Image size 1924x1556, FOV: 200 degrees, ultra-widefield fundus photograph: 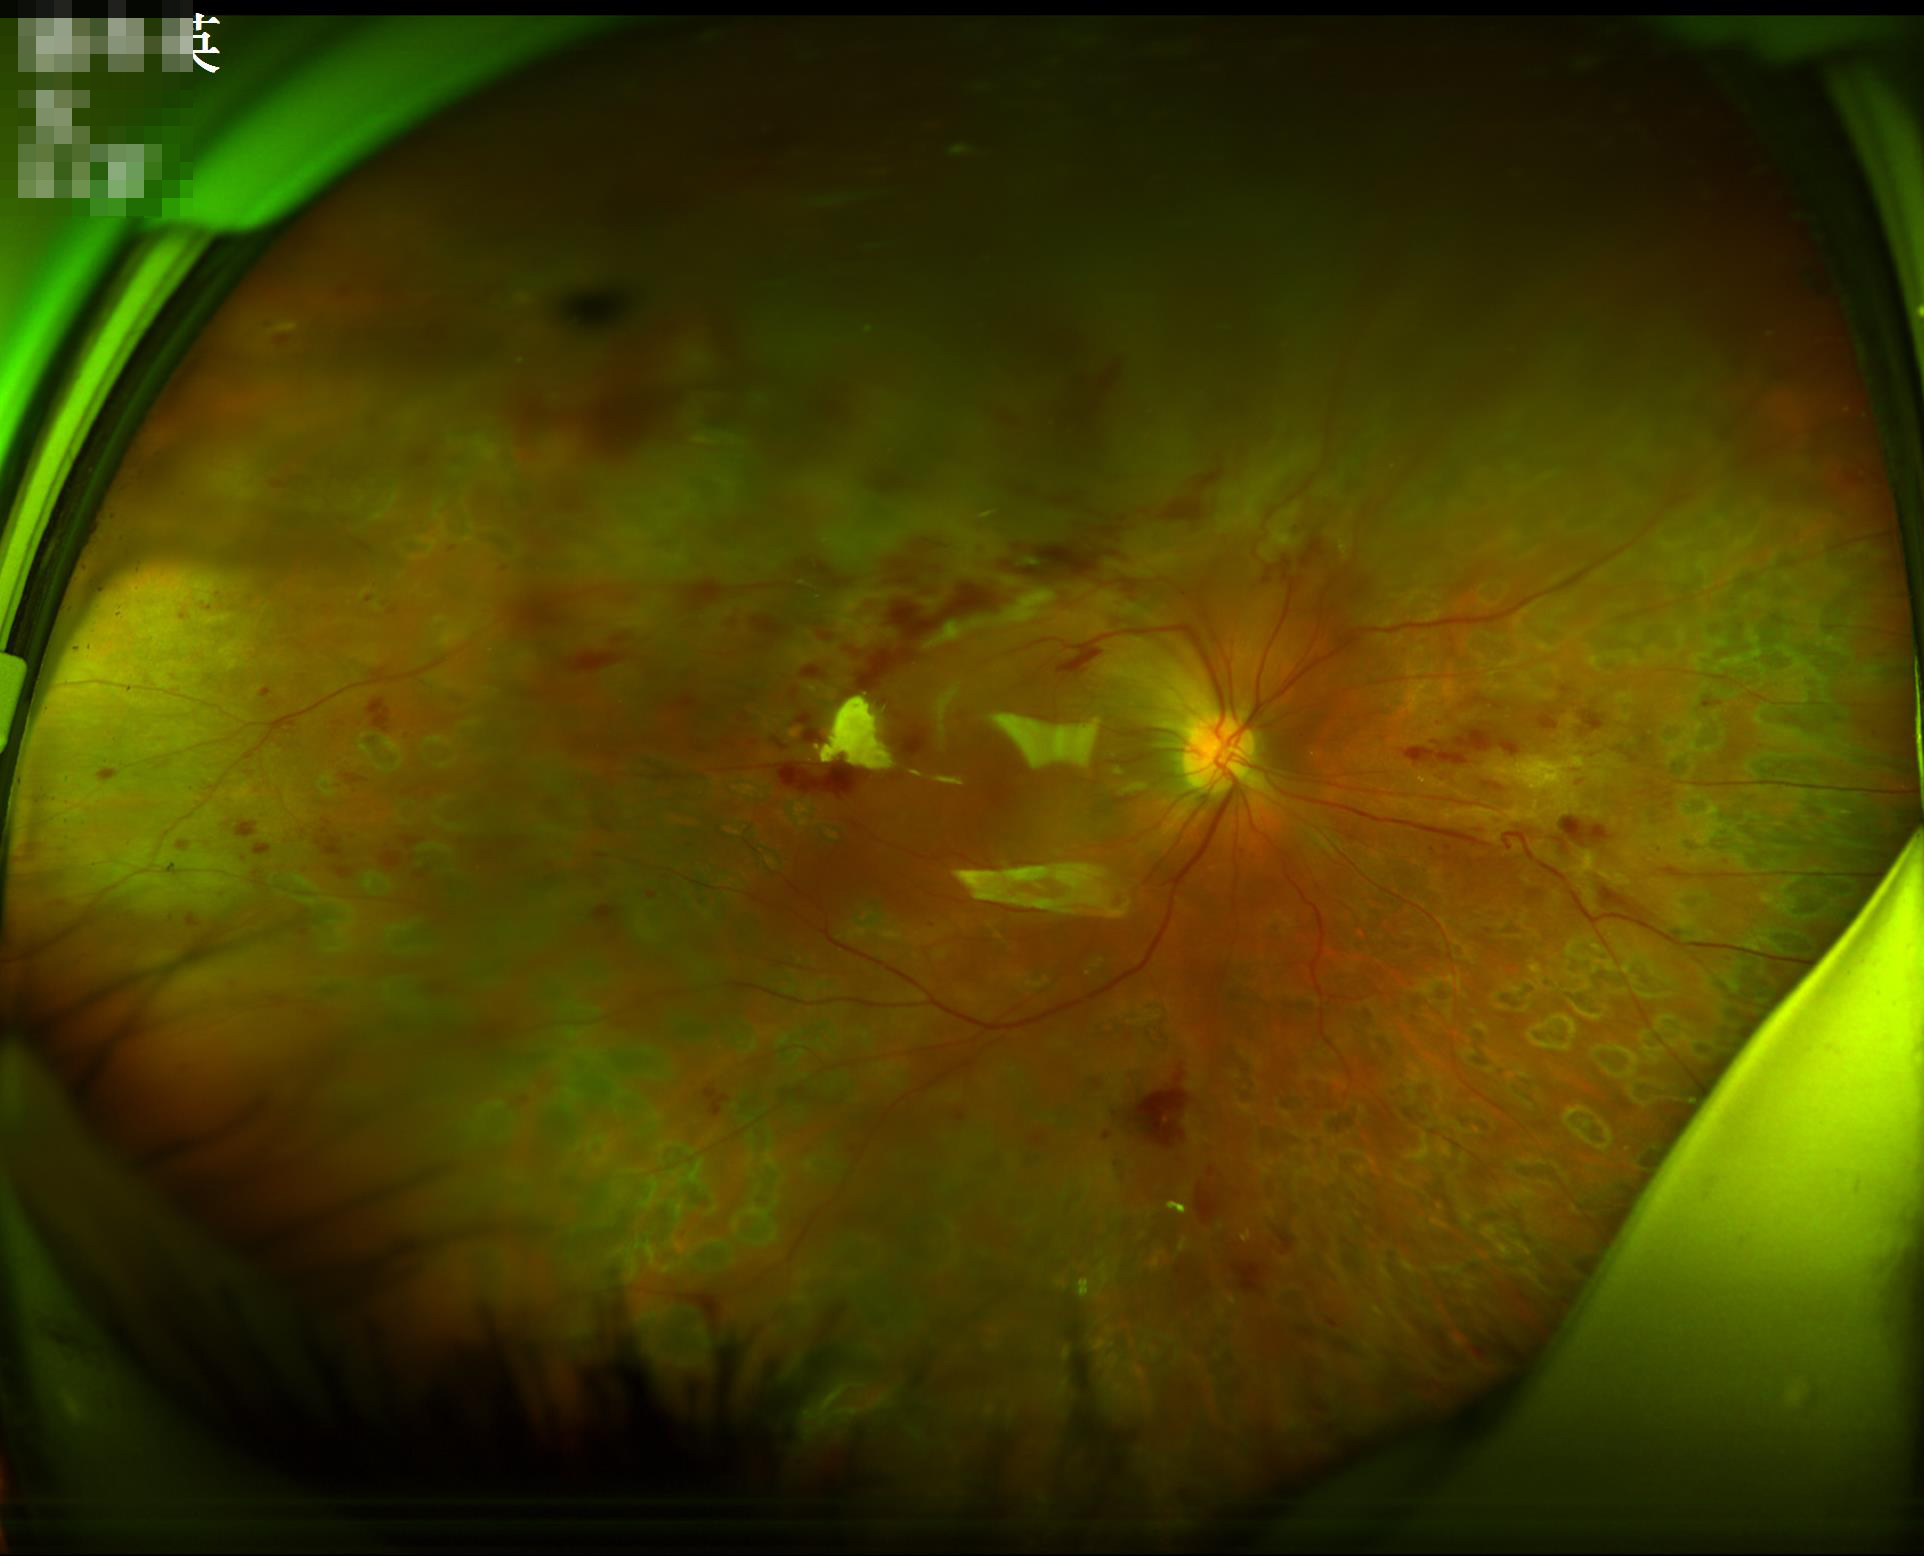 Quality grading:
- overall: low
- illumination: suboptimal
- contrast: good
- sharpness: reduced